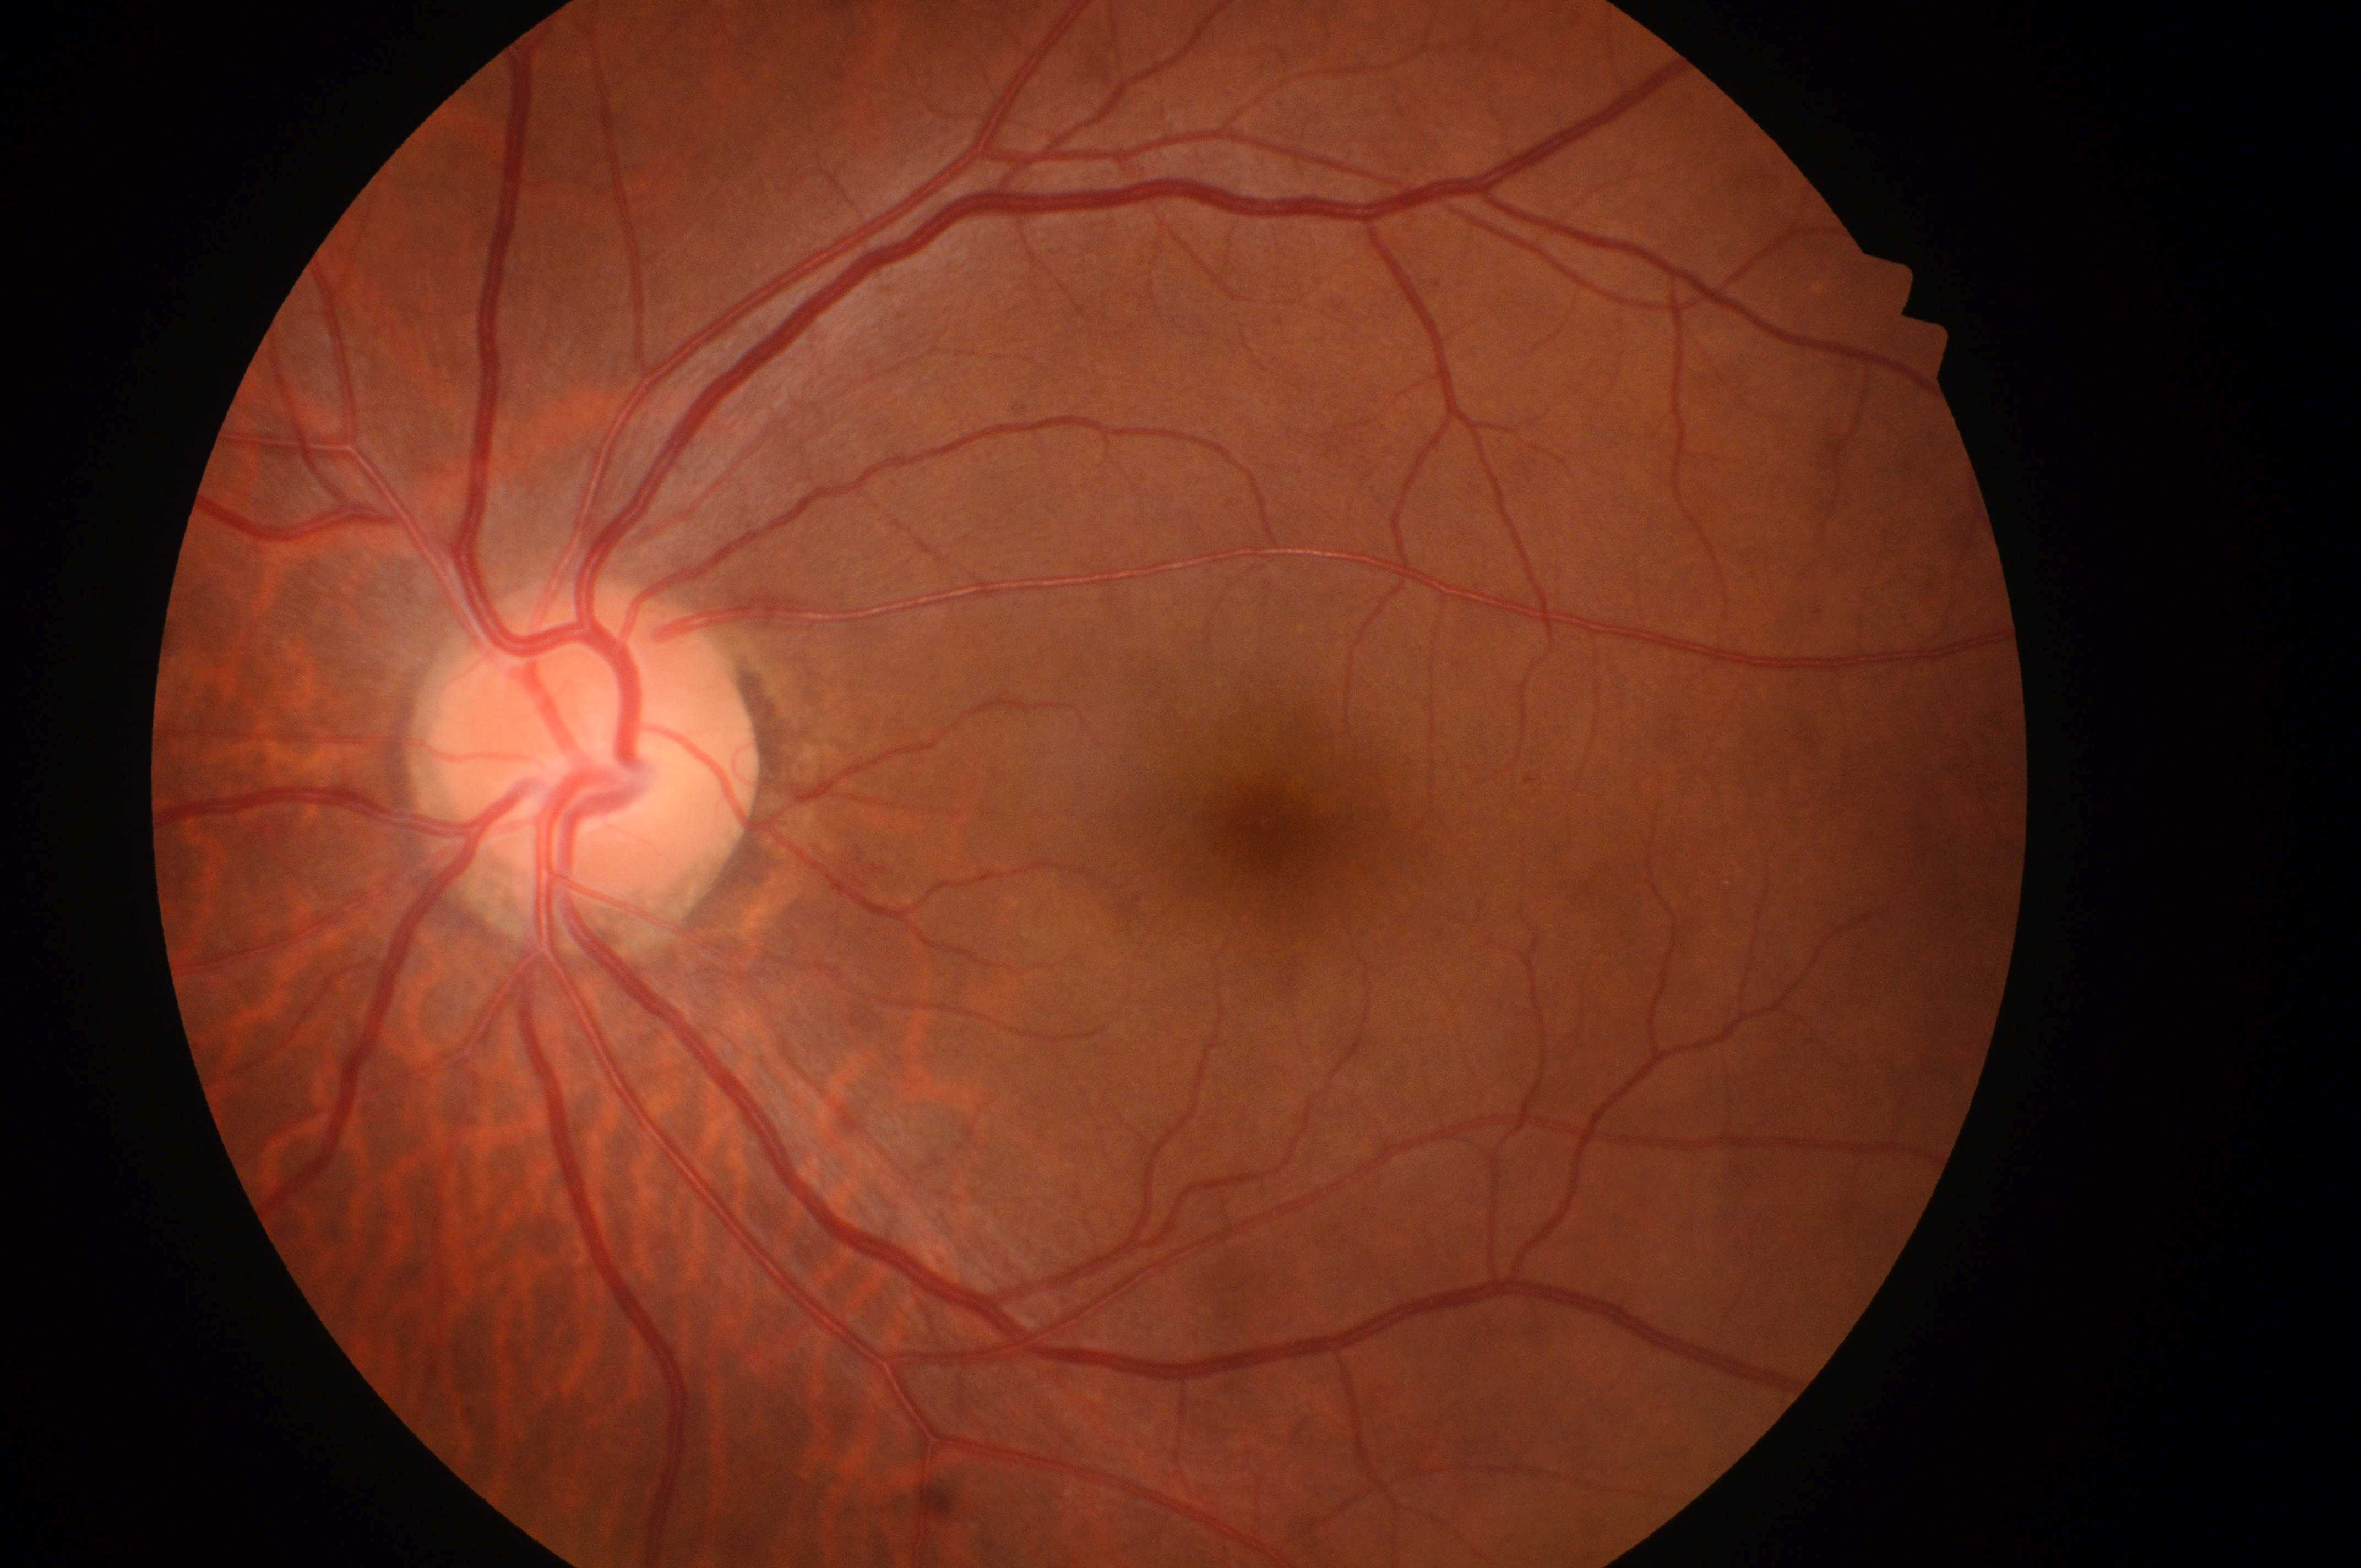 DR grade: 2 (moderate NPDR).
DME grade: high risk (2).
The macula center is at (1263, 829).
The ONH is at (587, 752).
The retinopathy is classified as non-proliferative diabetic retinopathy.
This is the left eye.